1932 by 1916 pixels; 45-degree field of view — 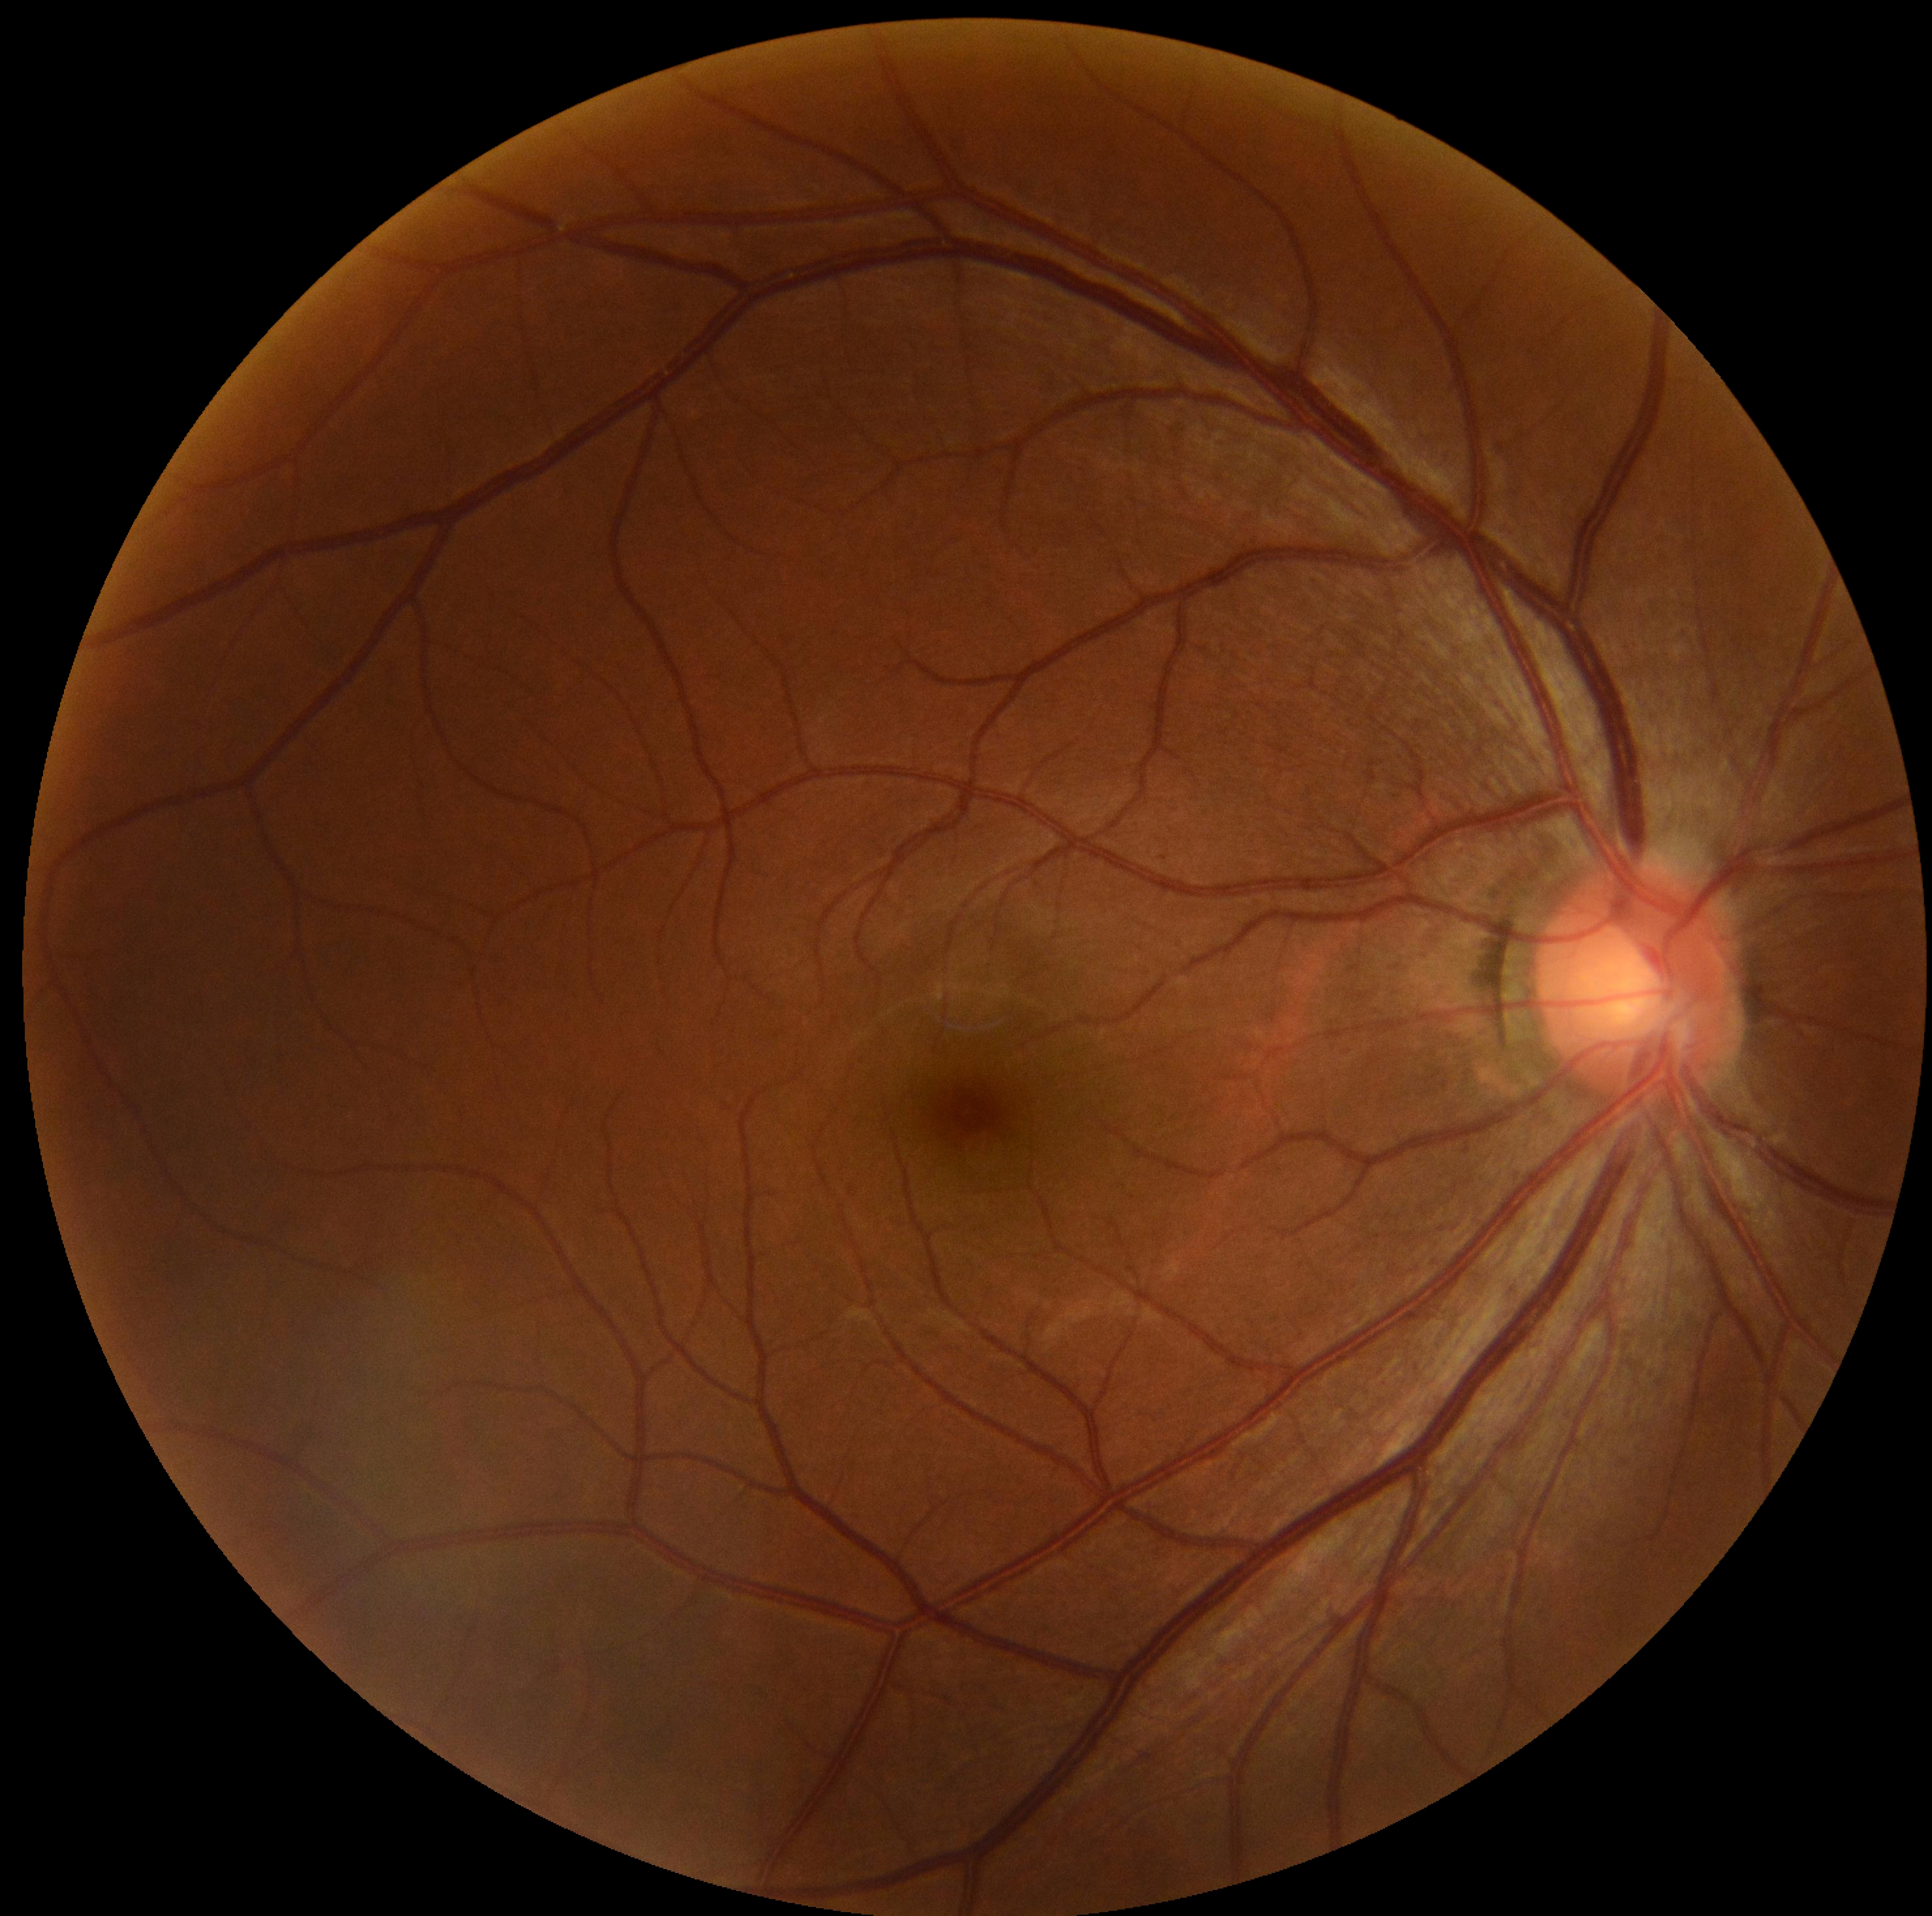 No DR findings.
DR is grade 0 — no visible signs of diabetic retinopathy.